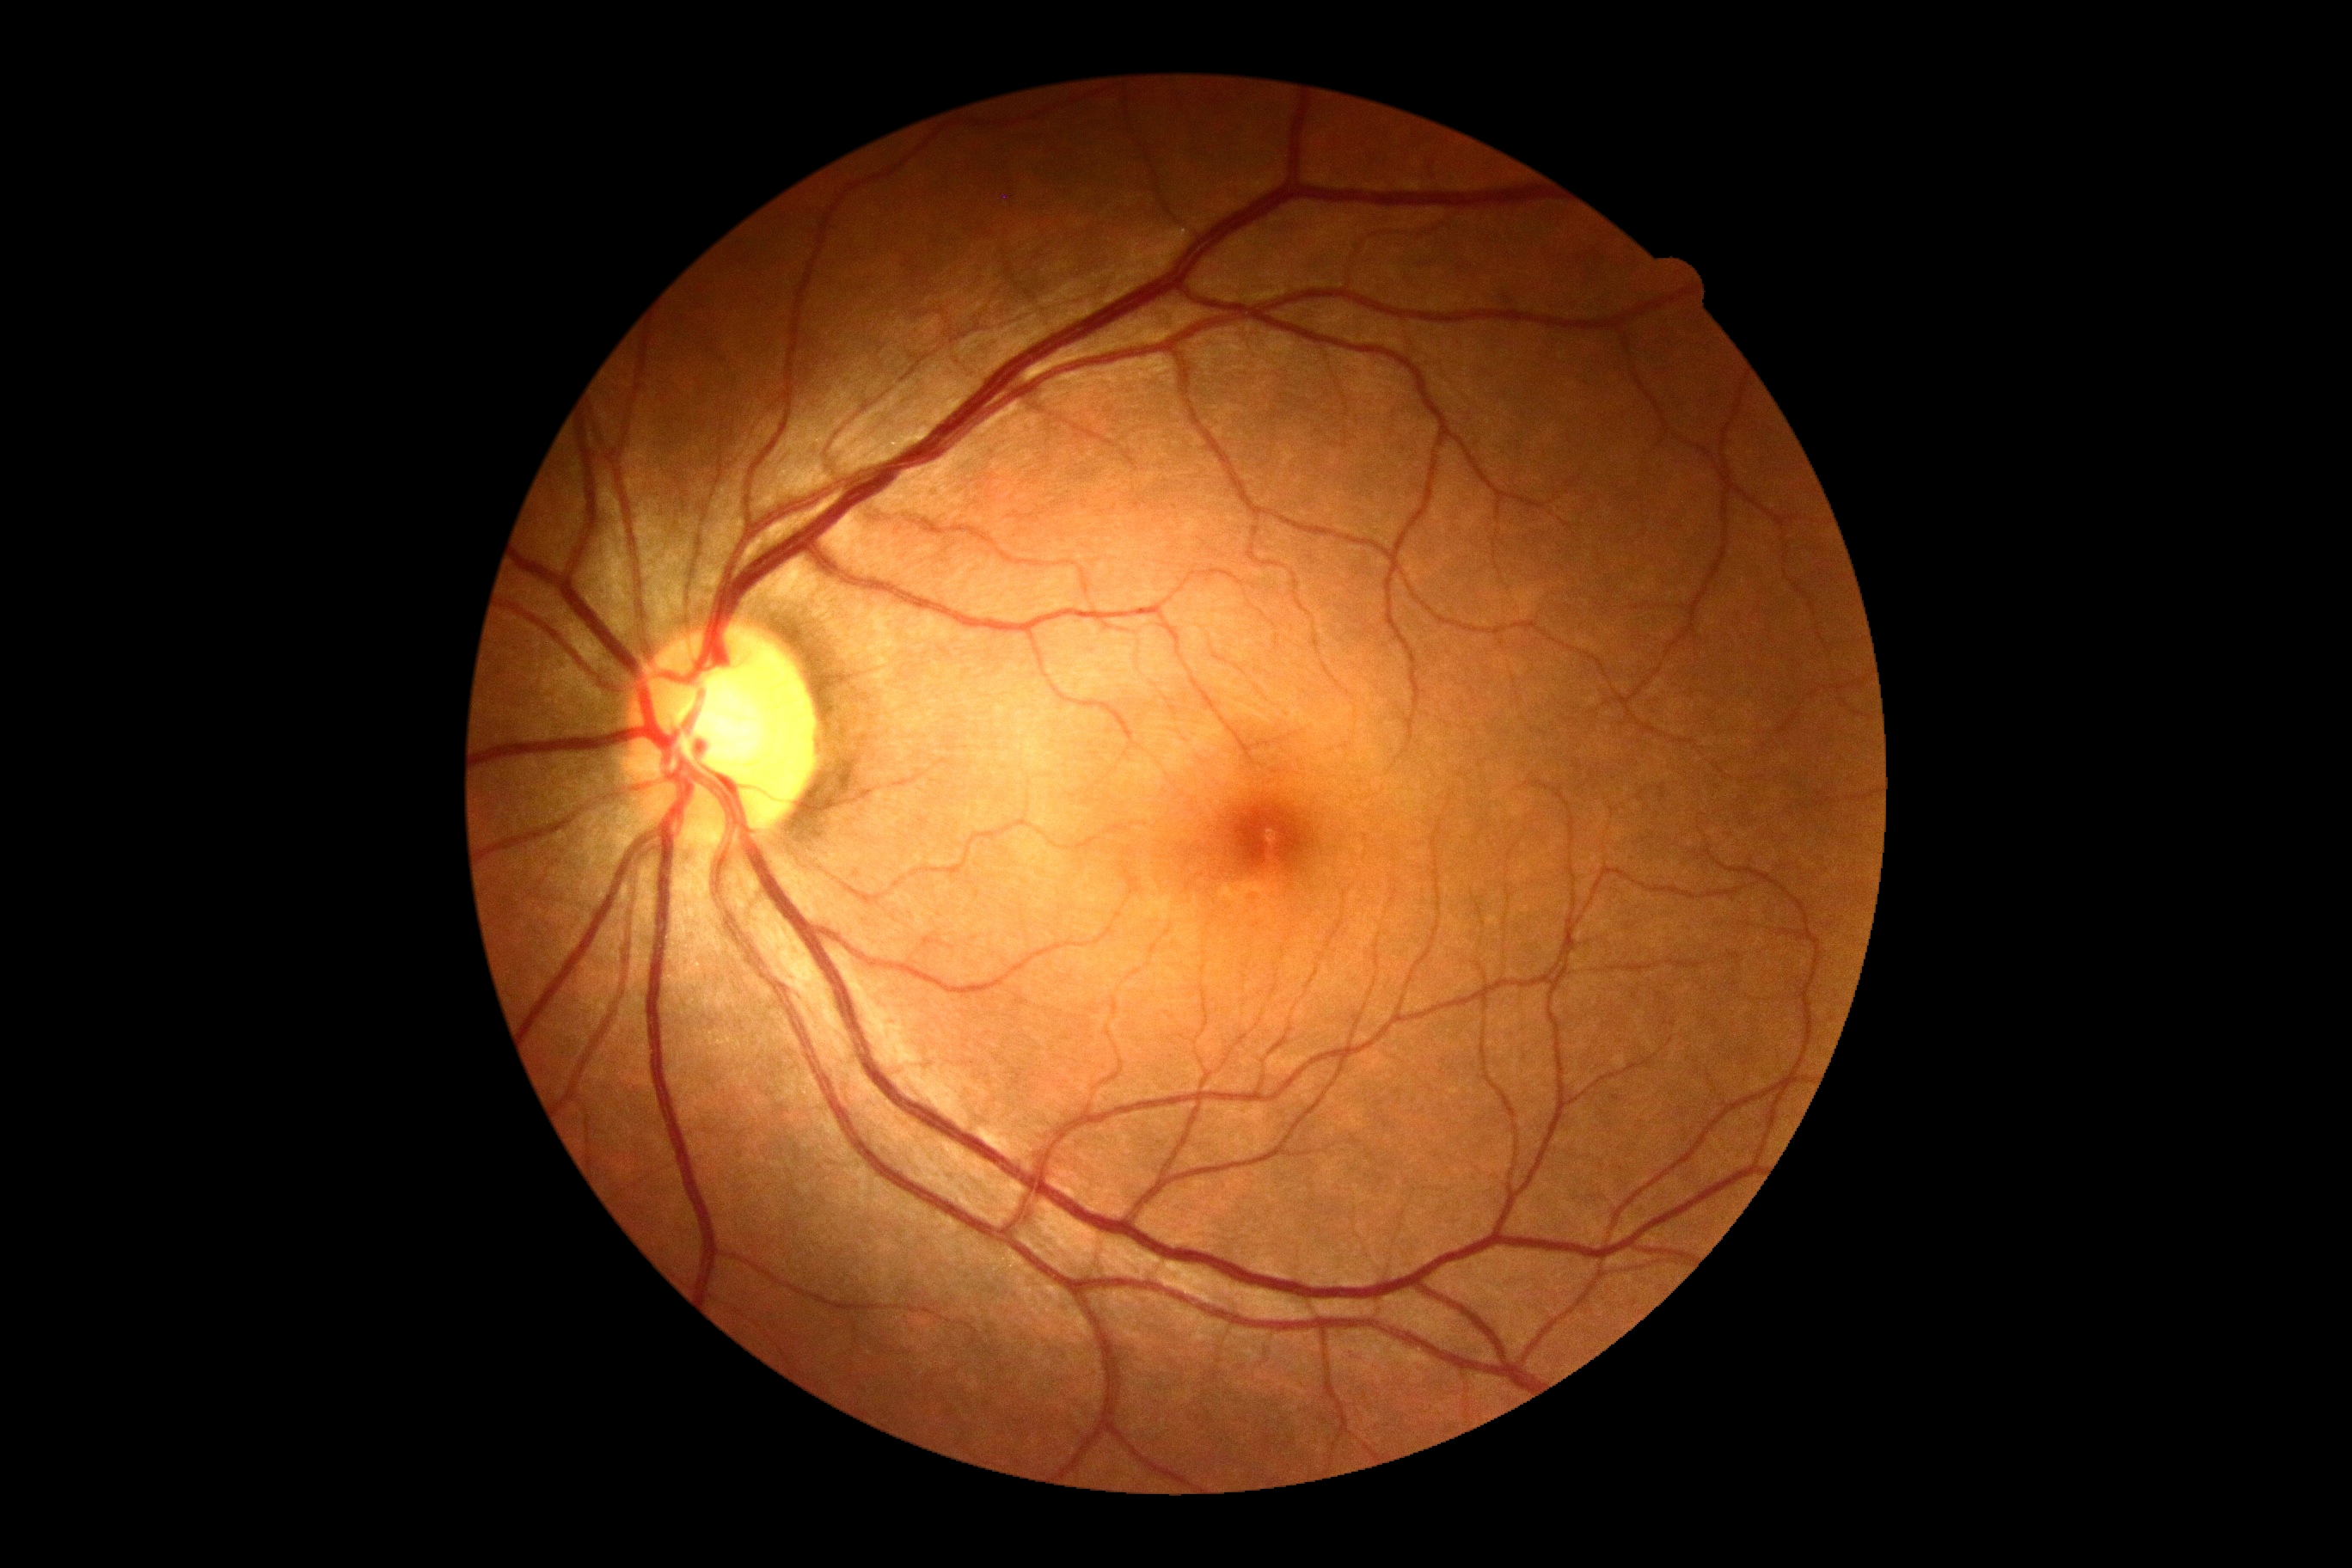
No diabetic retinal disease findings. Diabetic retinopathy grade: 0.